Image size 640x480 · RetCam wide-field infant fundus image
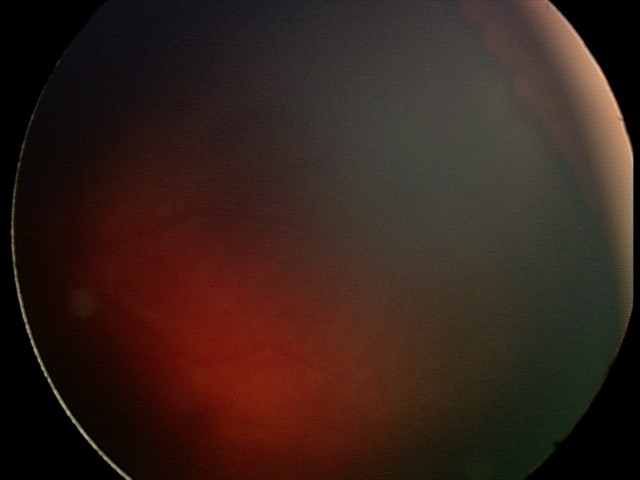 From an examination with diagnosis of retinal hemorrhages.